Wide-field fundus photograph from neonatal ROP screening; Clarity RetCam 3, 130° FOV.
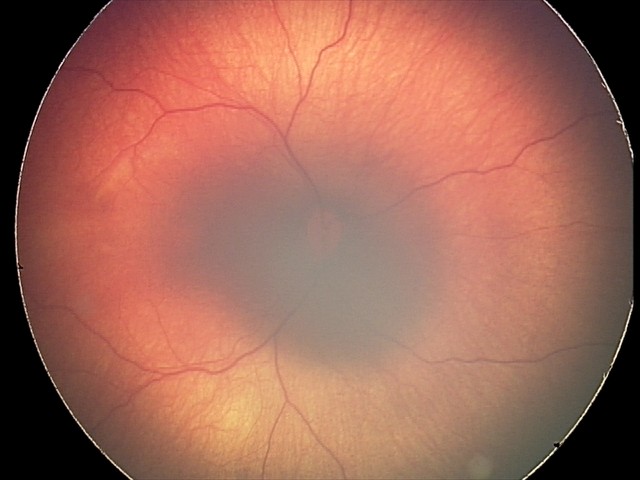
Examination diagnosed as retinal hemorrhages.